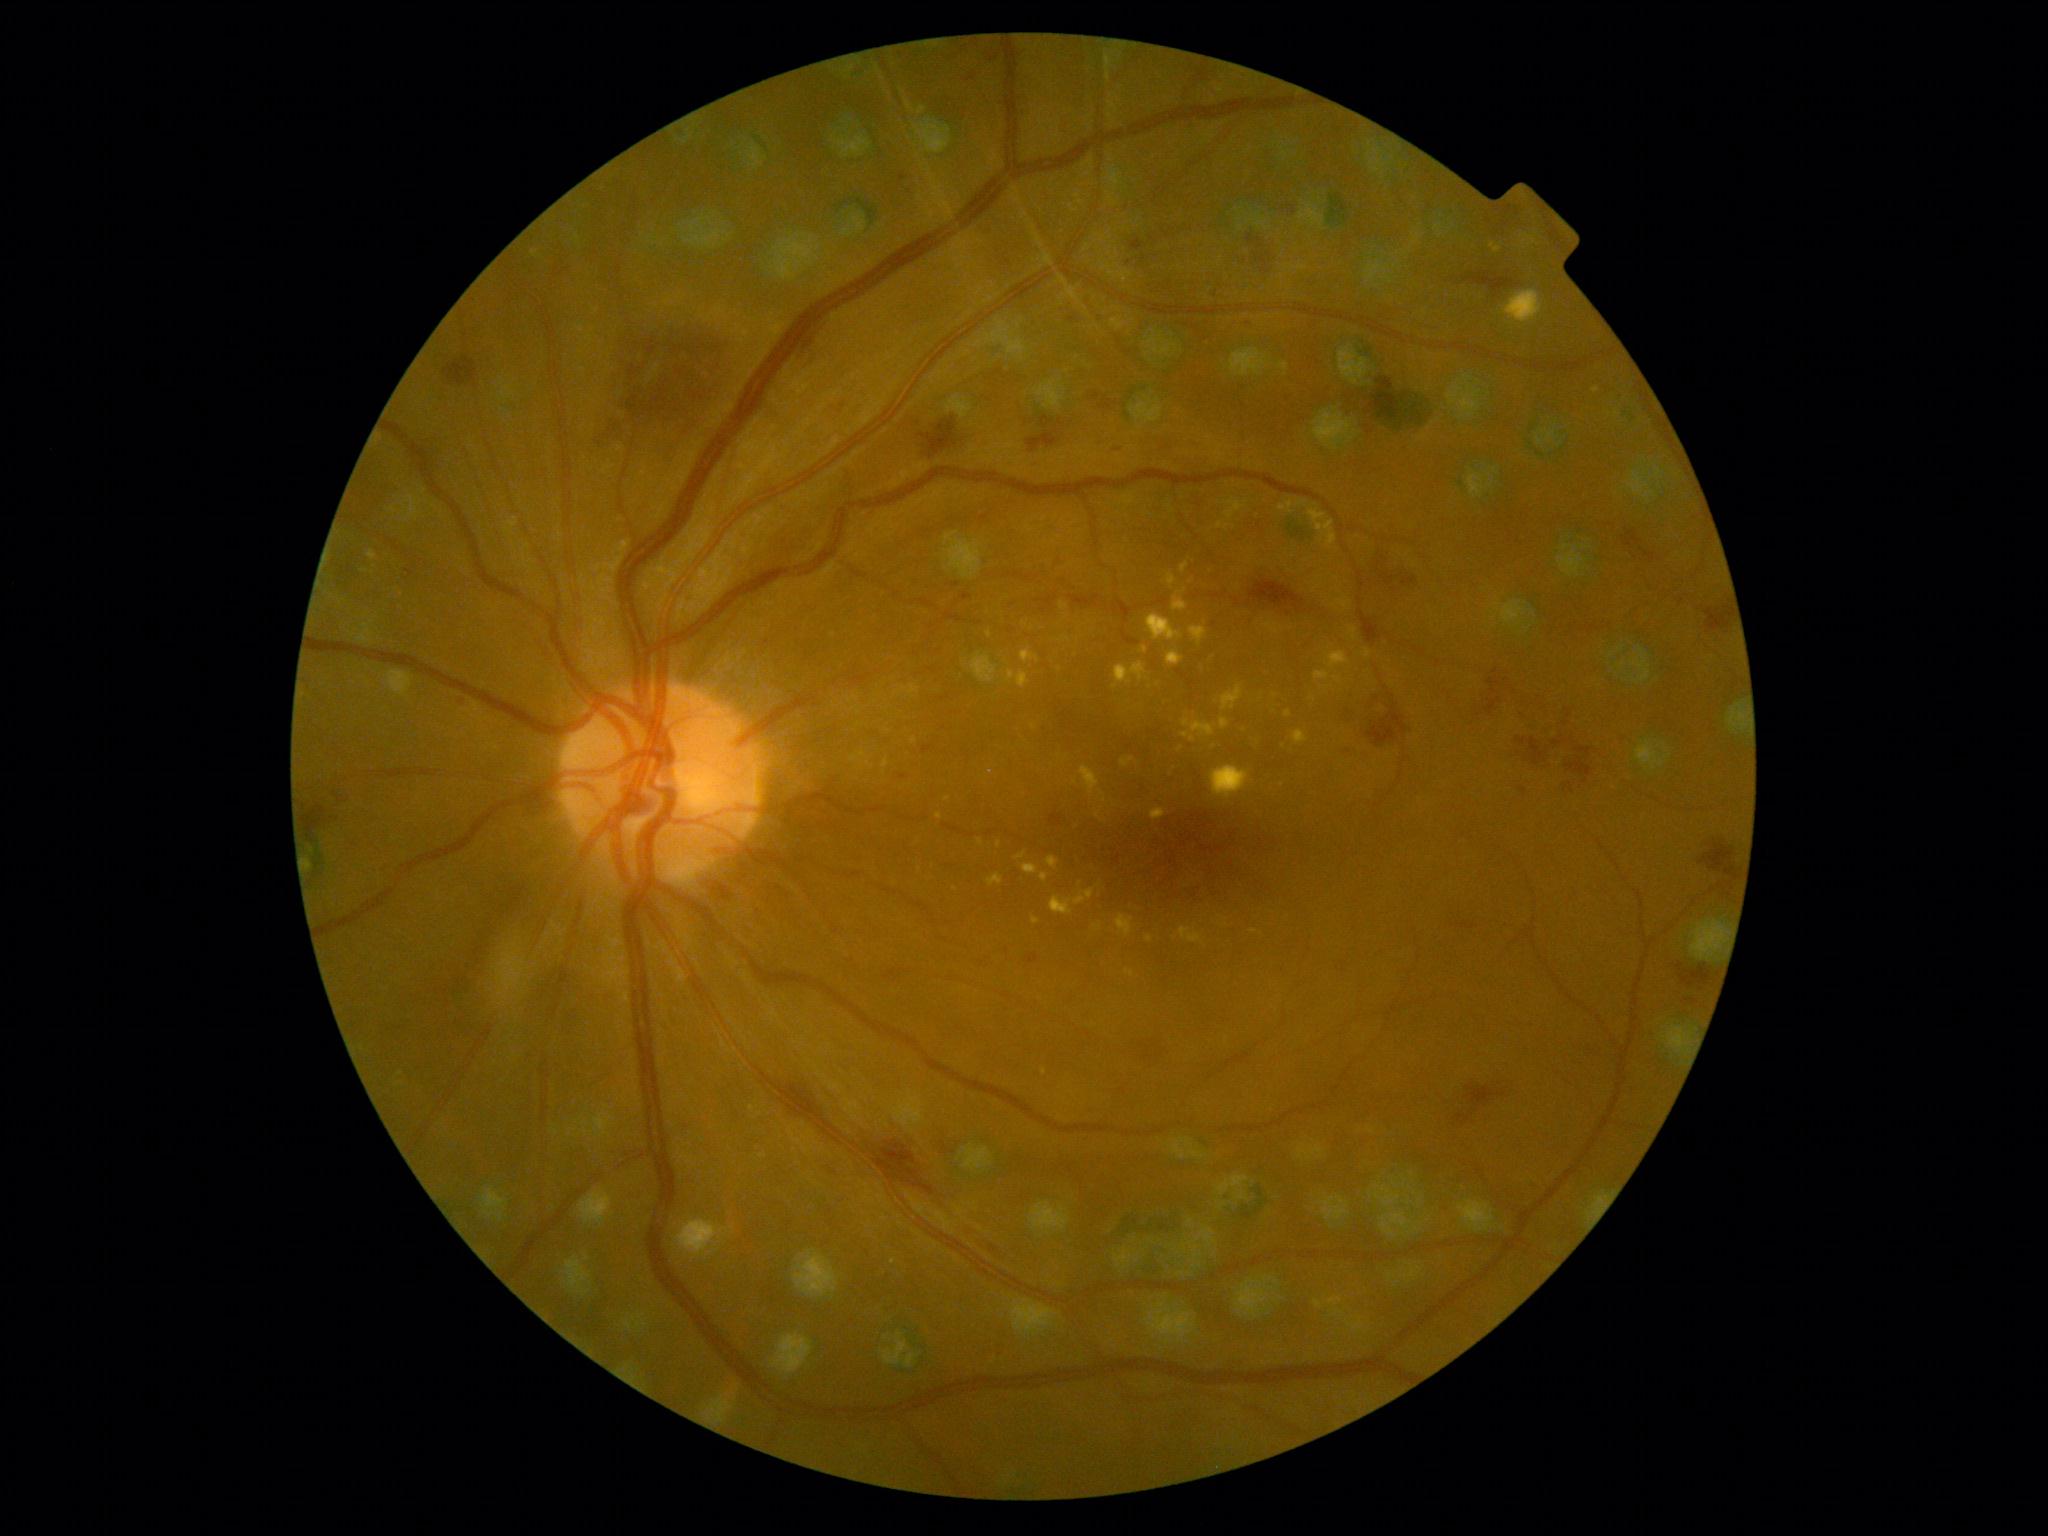 Diabetic retinopathy (DR) is moderate NPDR (grade 2) — more than just microaneurysms but less than severe NPDR; non-proliferative diabetic retinopathy. Hard exudates (EXs) include lesions at Rect(1222, 686, 1244, 712) | Rect(1315, 672, 1331, 680) | Rect(1178, 590, 1186, 596) | Rect(1198, 653, 1211, 672) | Rect(1181, 563, 1189, 574) | Rect(605, 540, 632, 573) | Rect(1006, 670, 1030, 689) | Rect(1141, 646, 1148, 654) | Rect(1310, 508, 1338, 550) | Rect(1247, 735, 1259, 747) | Rect(883, 759, 890, 770) | Rect(1191, 627, 1208, 646) | Rect(1151, 808, 1166, 821) | Rect(1280, 501, 1294, 514). Small EXs near [x=1276, y=695] | [x=914, y=741] | [x=1193, y=739] | [x=1036, y=921]. Hemorrhages (HEs) include lesions at Rect(1367, 378, 1401, 422) | Rect(331, 792, 344, 805) | Rect(1367, 703, 1408, 747) | Rect(900, 173, 907, 183) | Rect(801, 321, 825, 355) | Rect(1705, 607, 1733, 632) | Rect(906, 186, 914, 196) | Rect(964, 53, 999, 83) | Rect(1623, 530, 1643, 550) | Rect(775, 1085, 834, 1130) | Rect(454, 696, 469, 707) | Rect(1562, 782, 1577, 792) | Rect(1027, 954, 1039, 964). Small HEs near [x=1072, y=320] | [x=1701, y=989] | [x=1694, y=1001].